Color fundus image
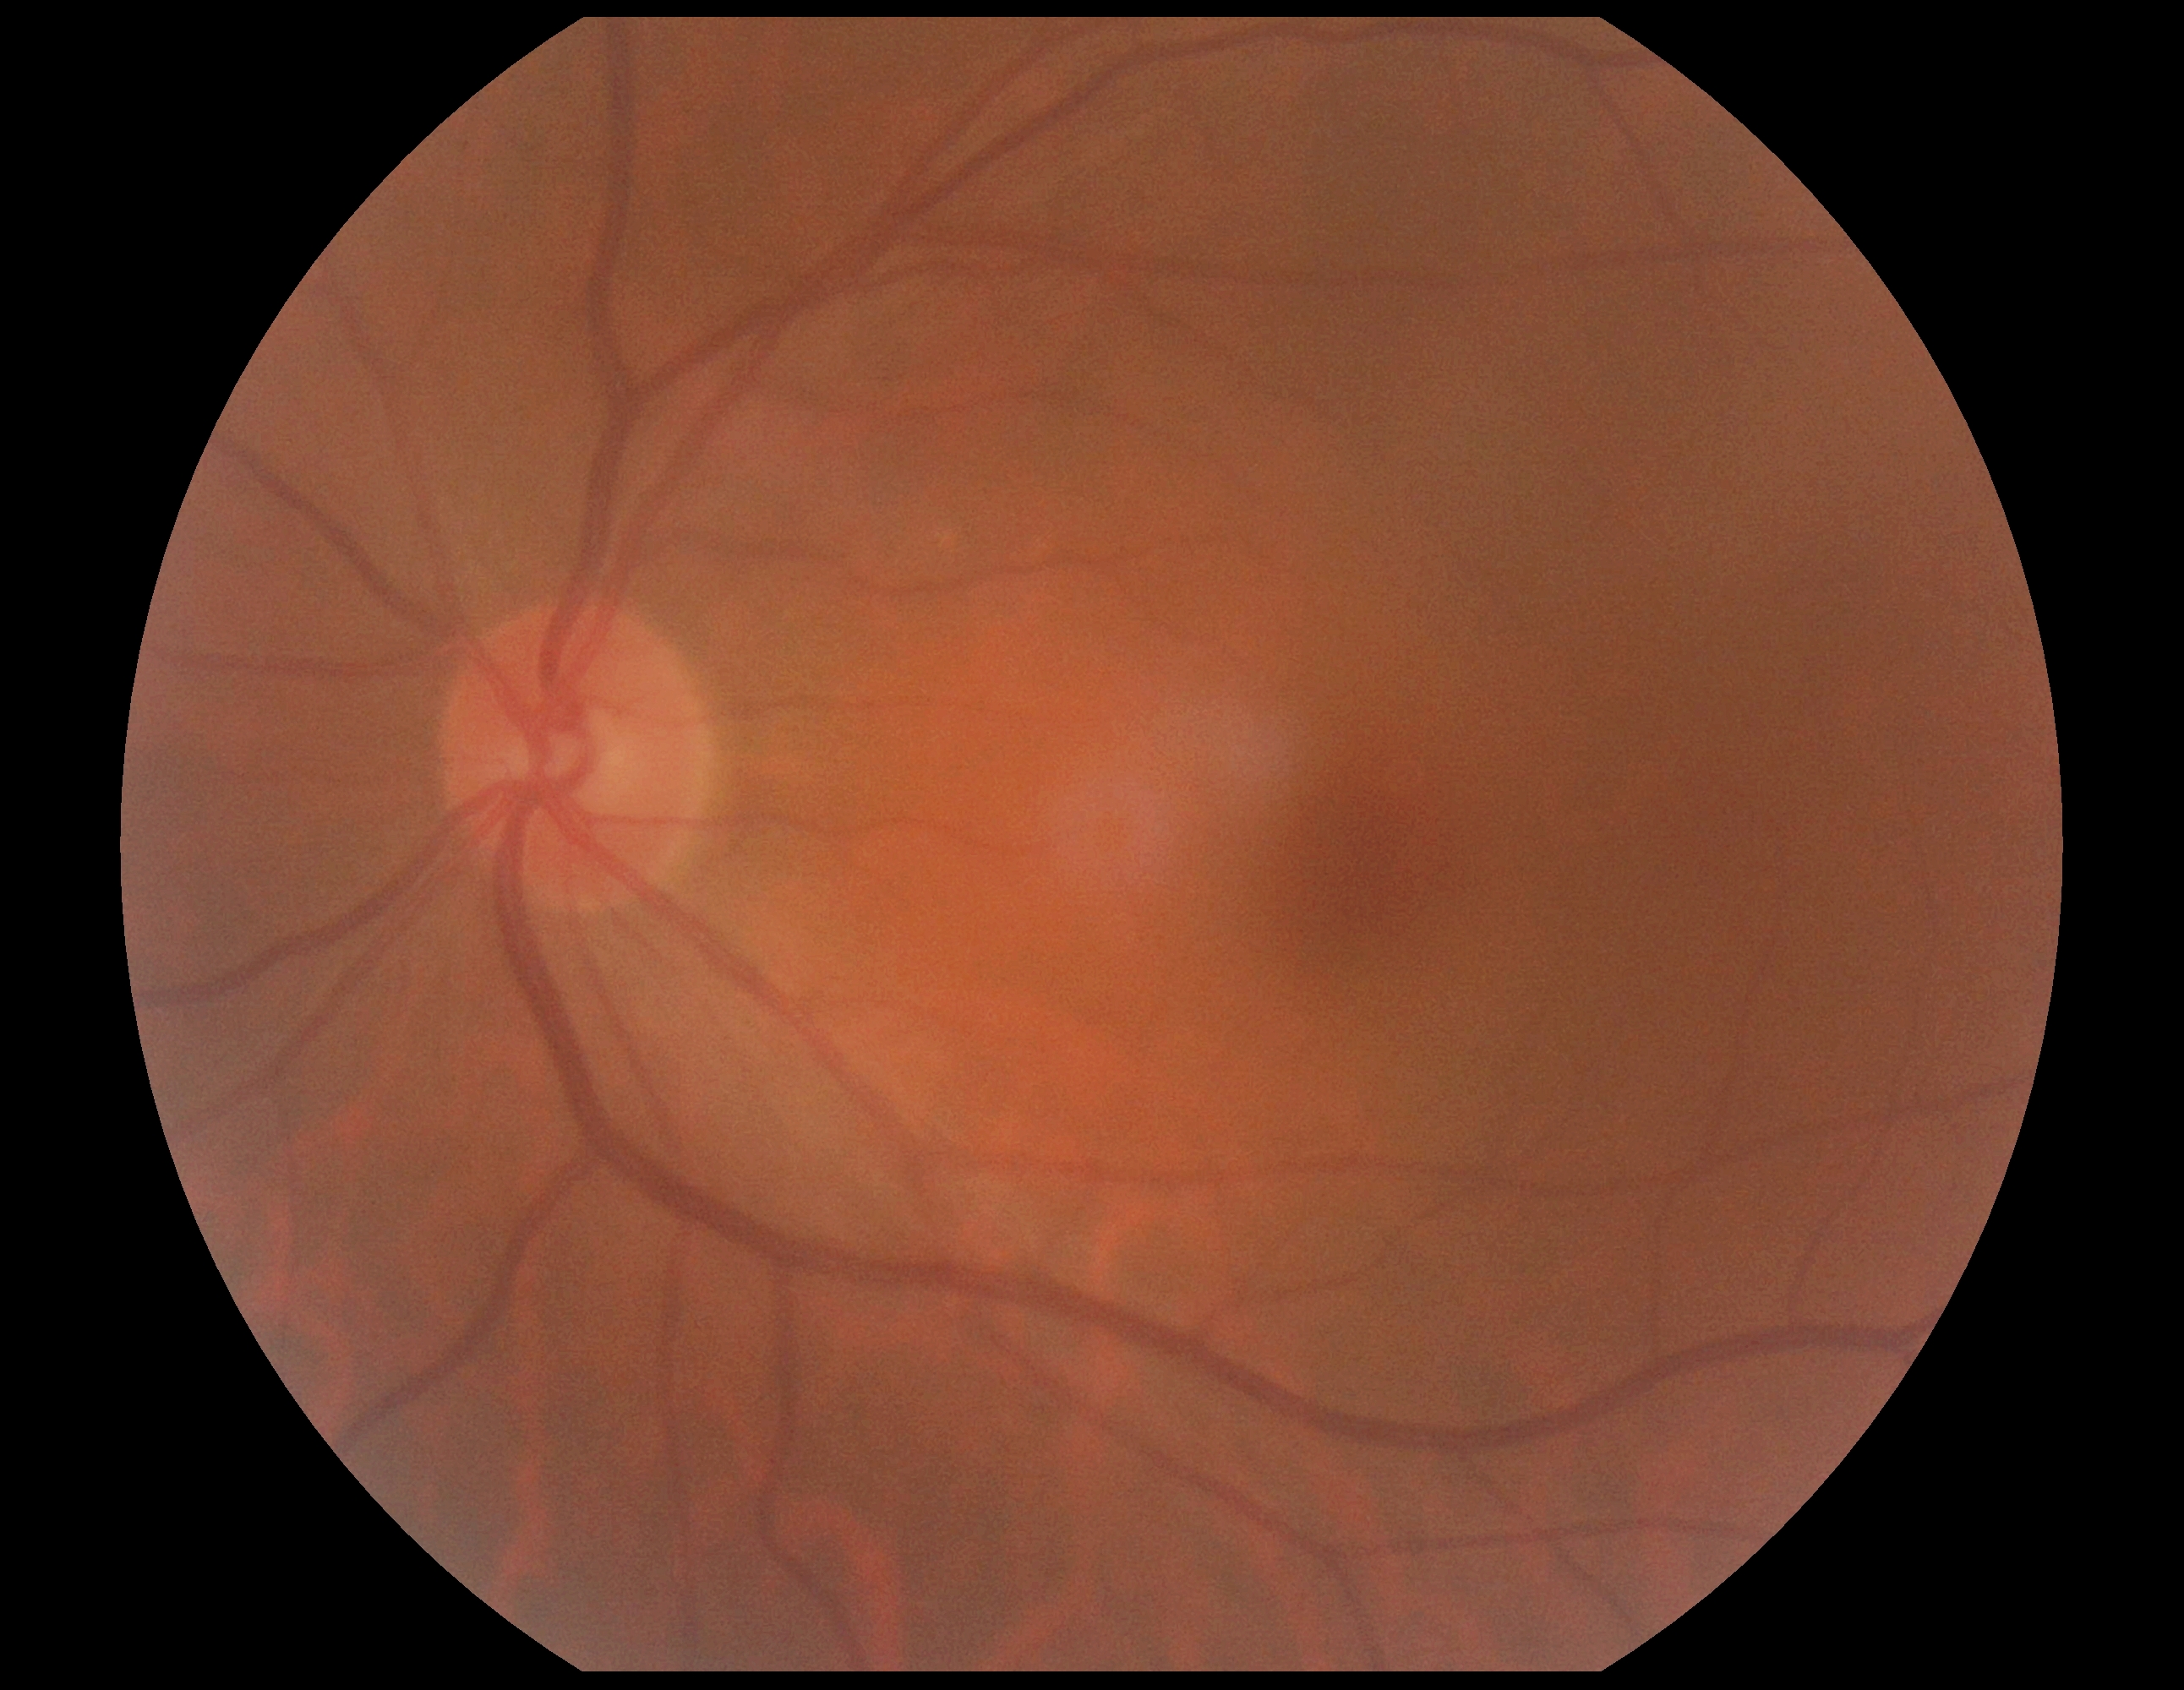
Retinopathy is grade 0.